FOV: 45 degrees, CFP:
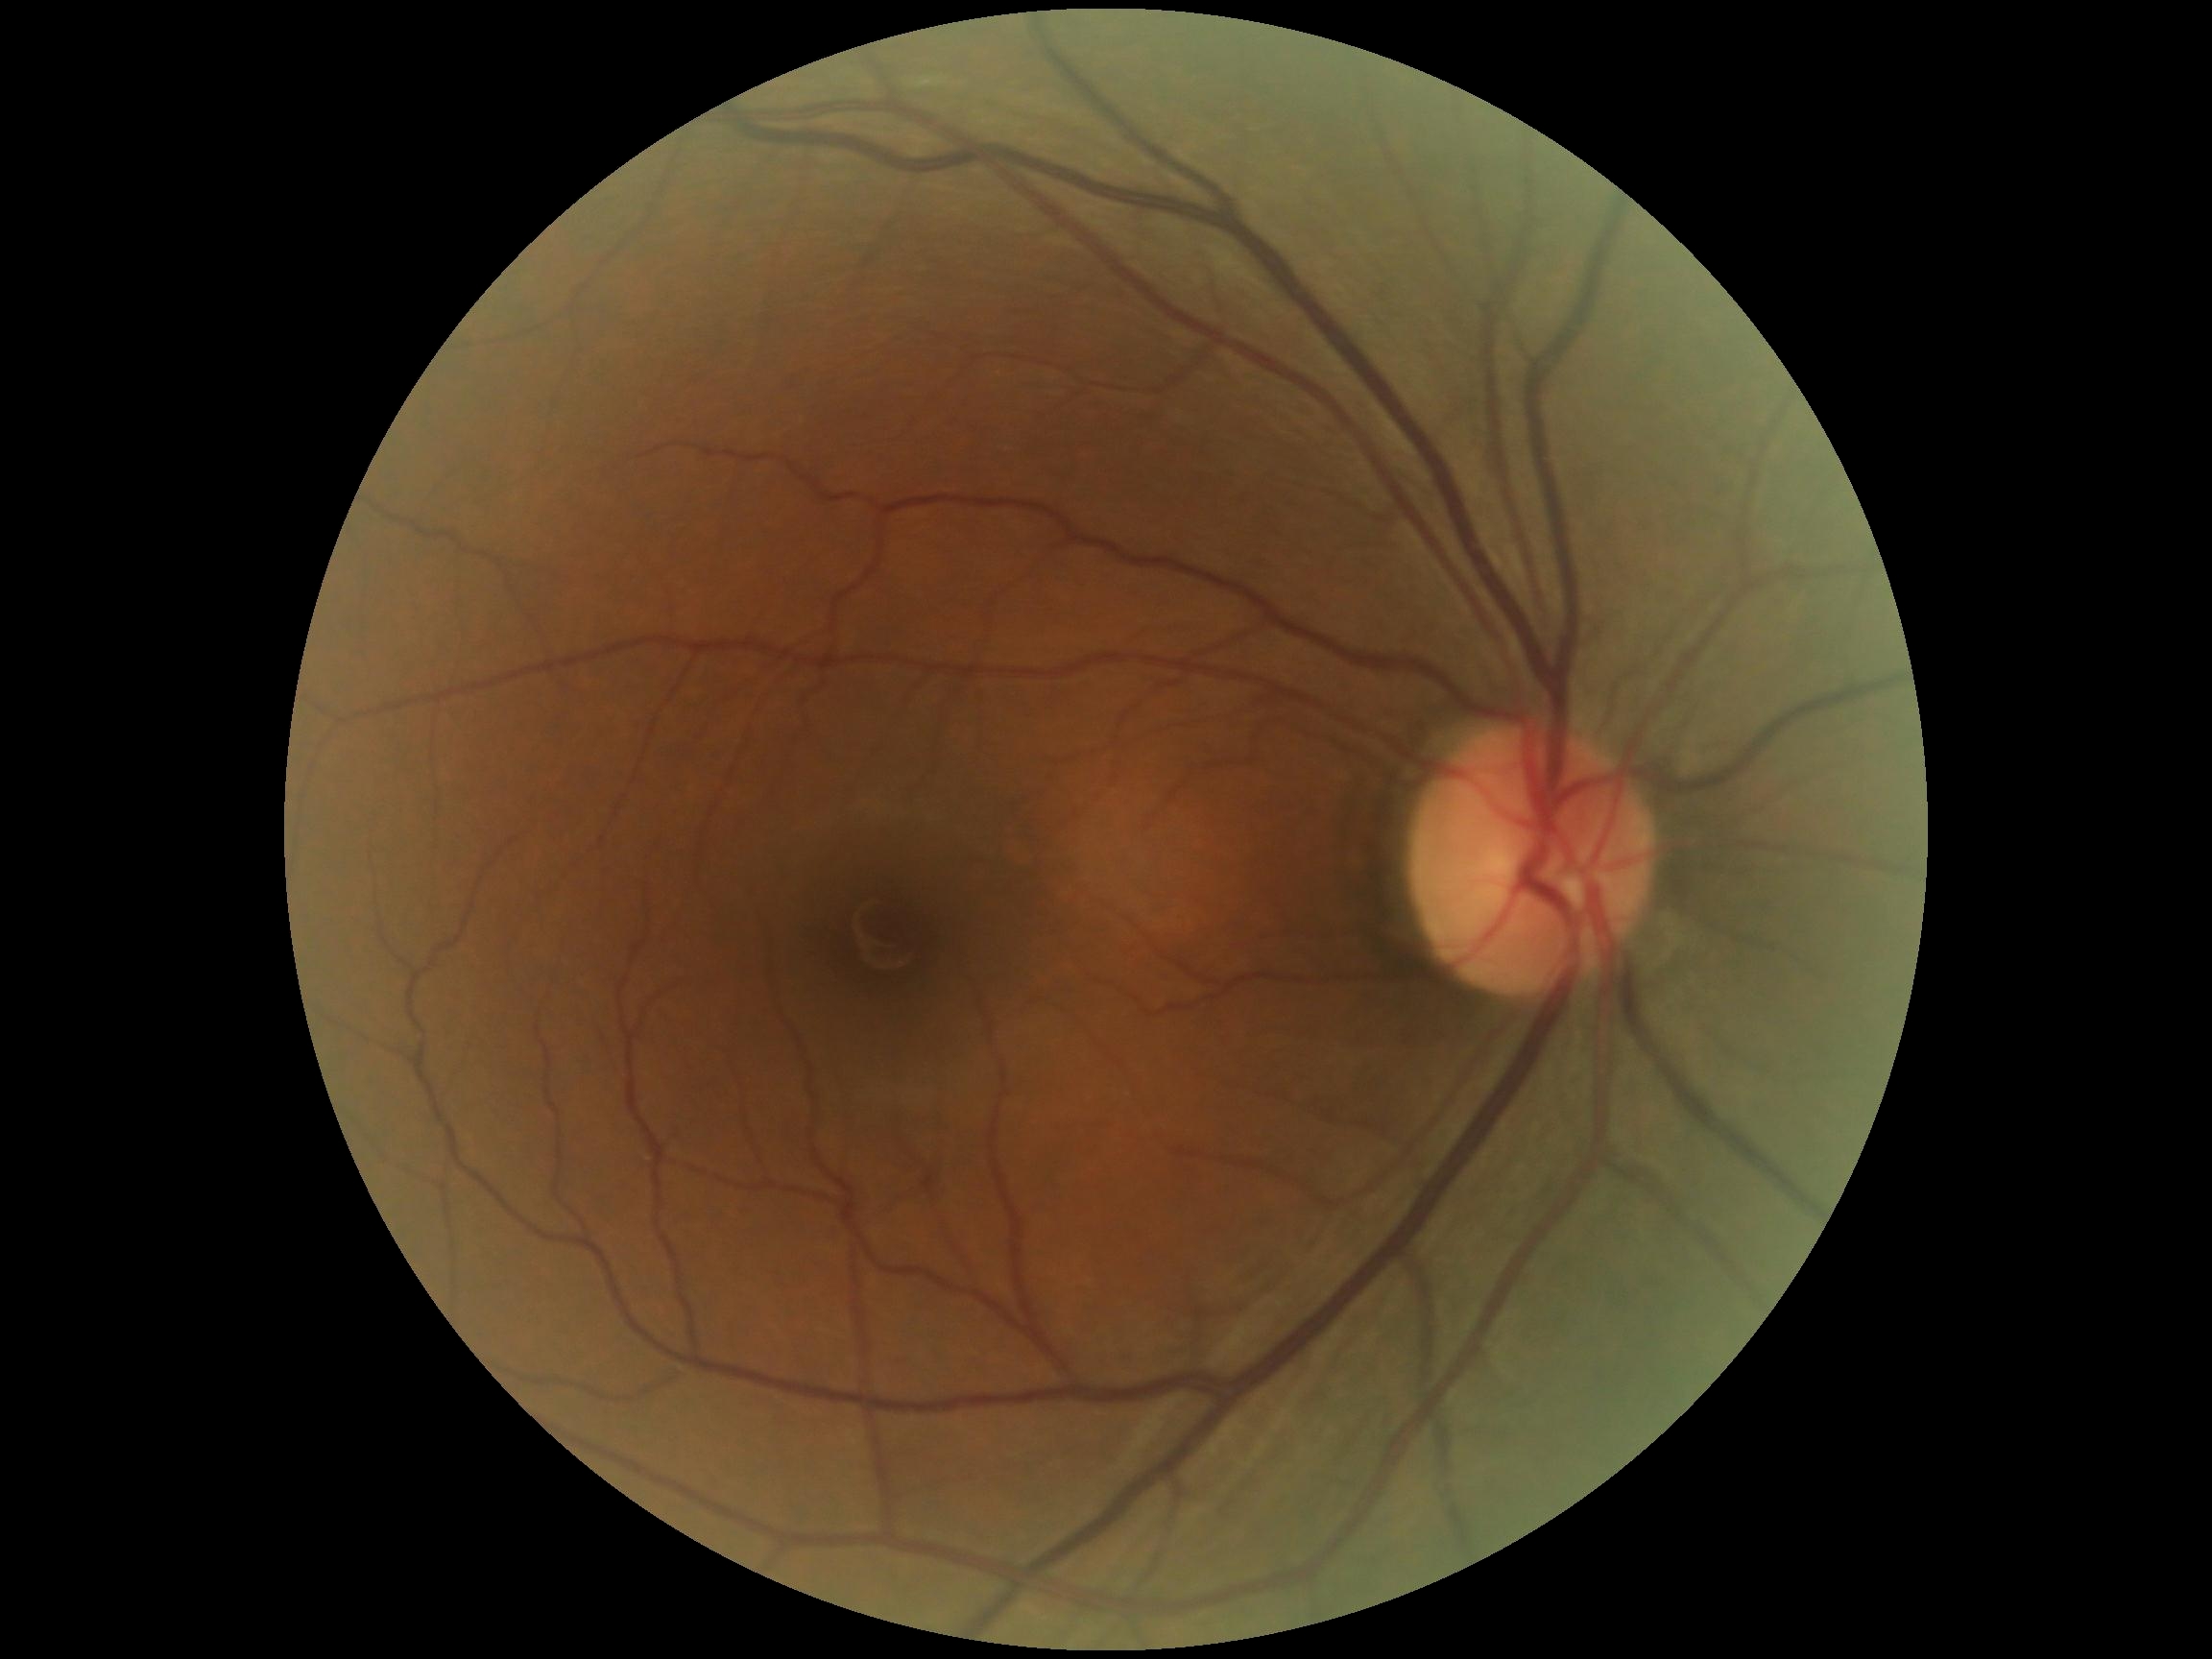
DR grade=0.